Fundus photo; 2346 x 1568 pixels; FOV: 45 degrees:
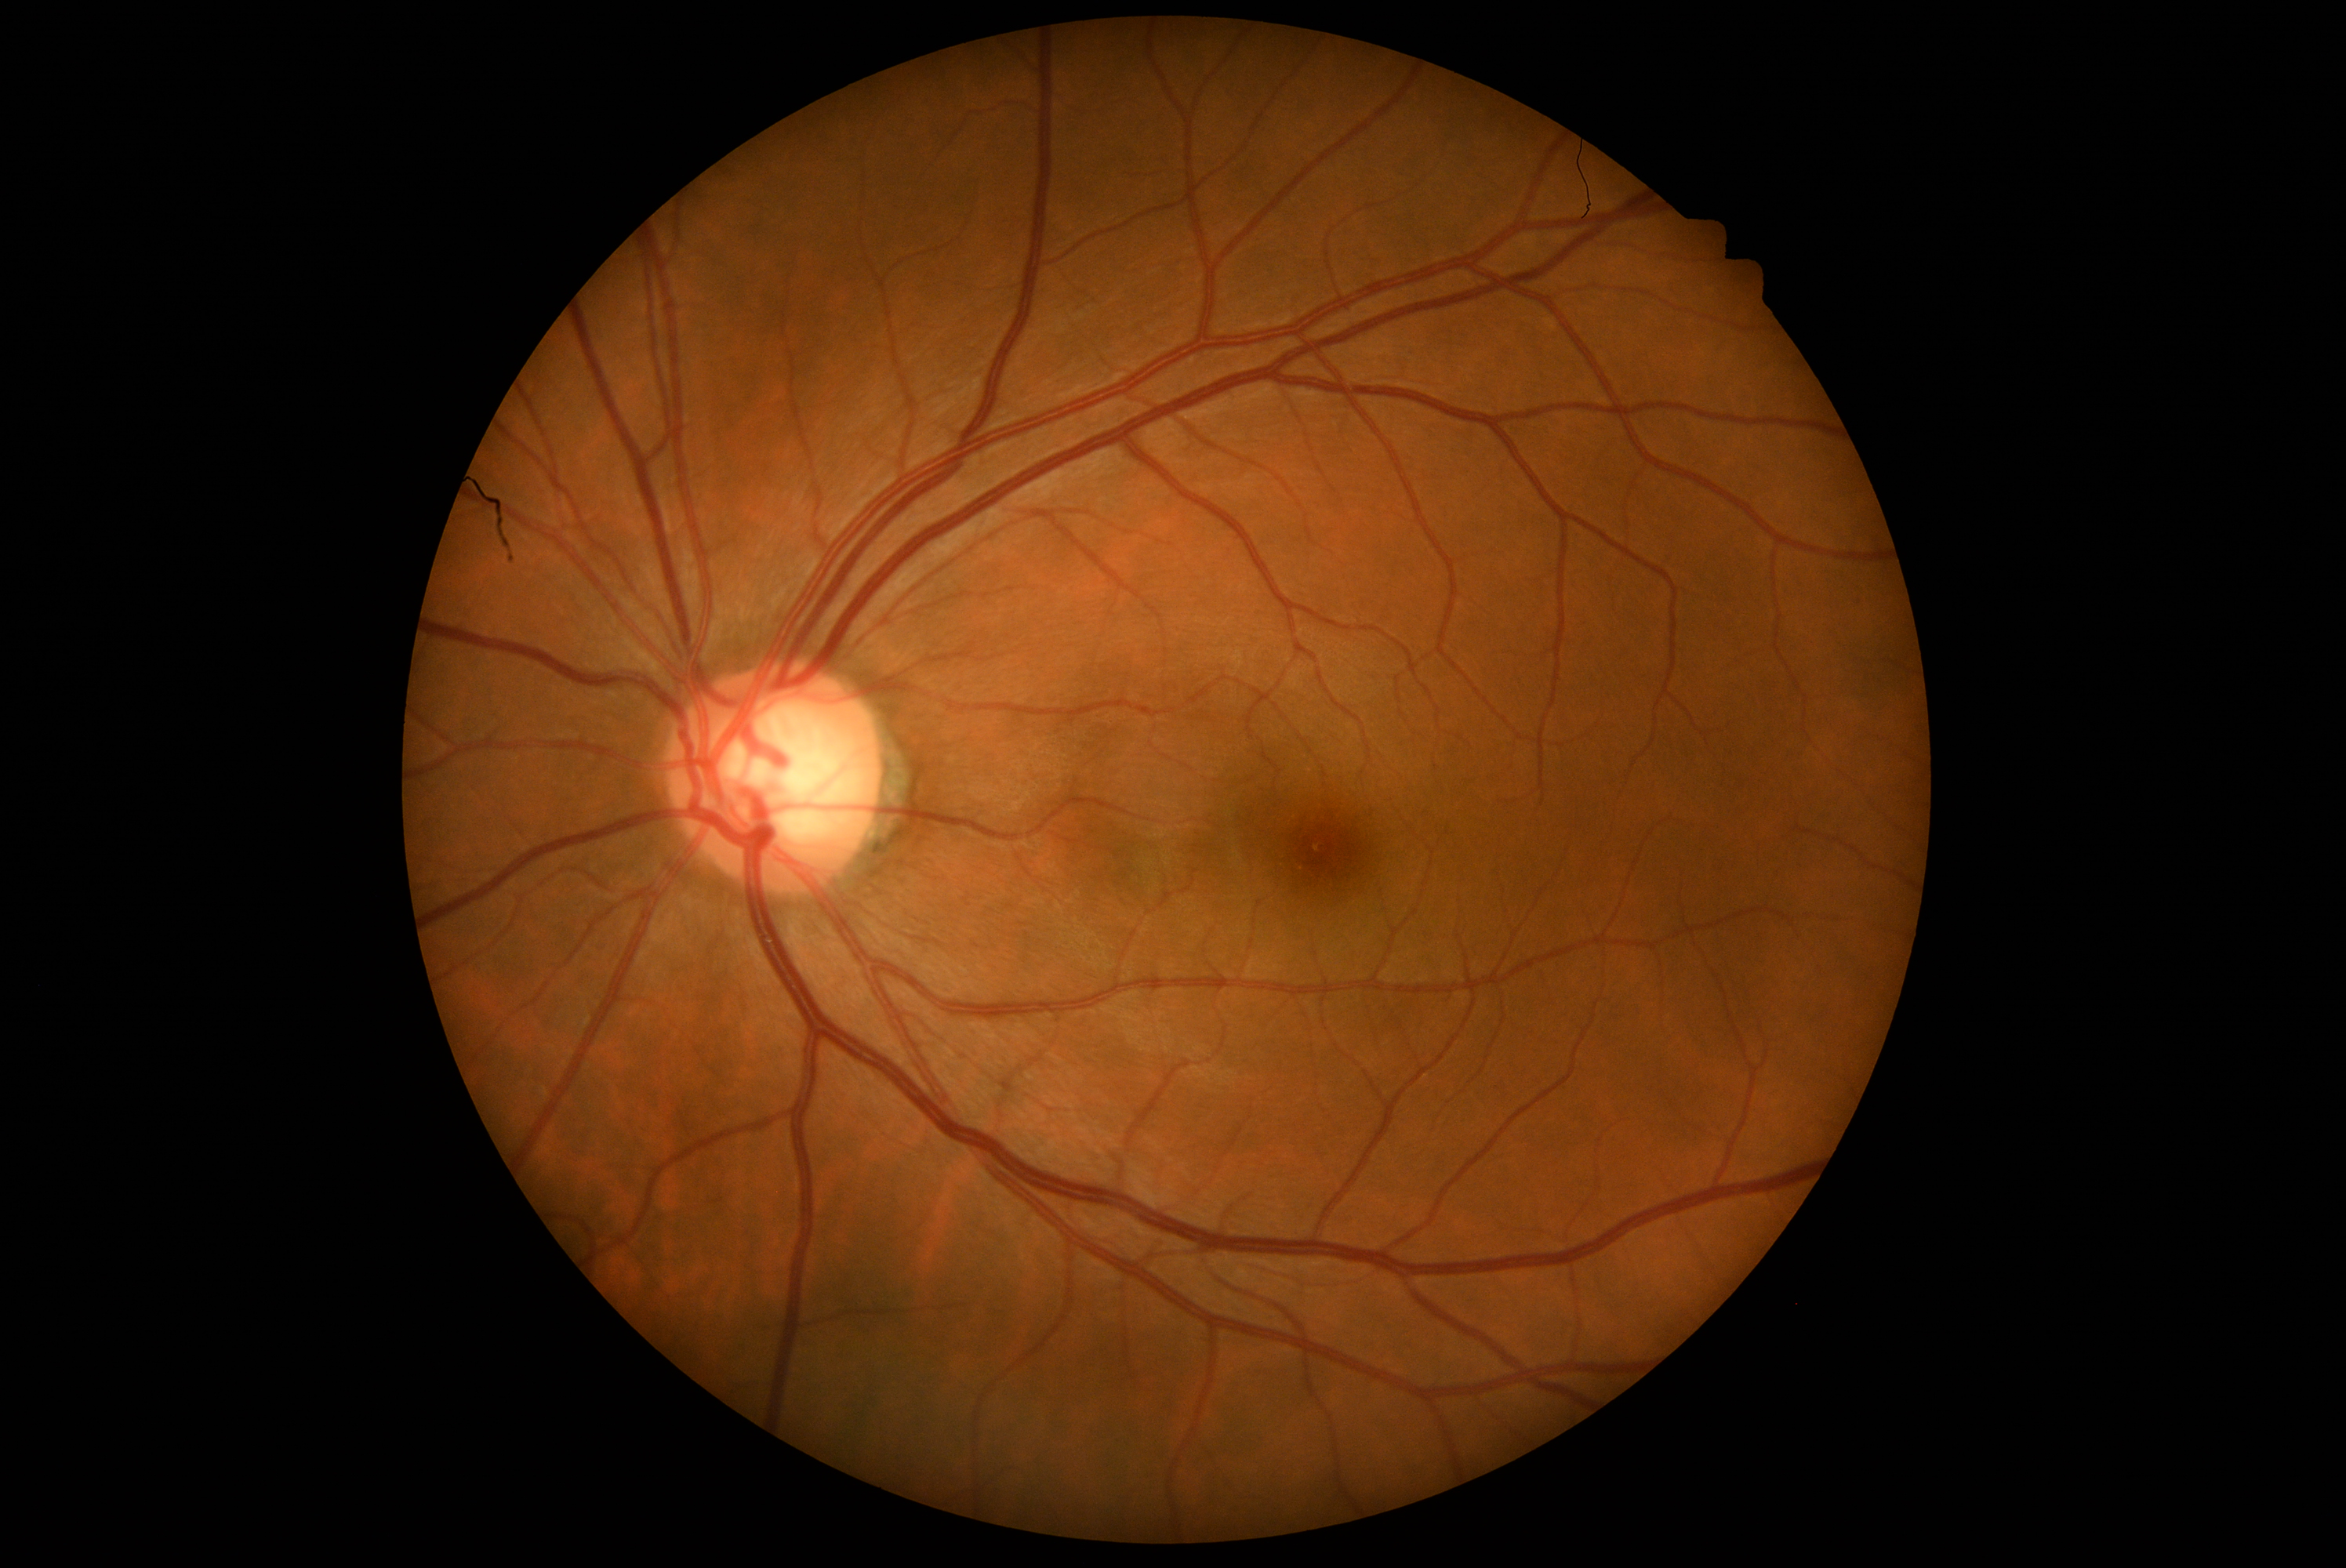

DR impression = no DR findings
DR grade = 0/4